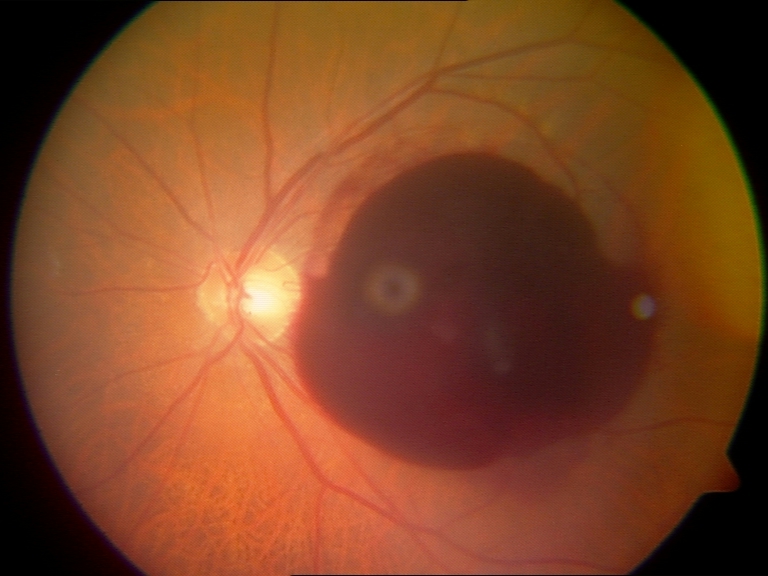

Classification: preretinal hemorrhage.